Wide-field fundus photograph from neonatal ROP screening · 640x480px · acquired on the Clarity RetCam 3.
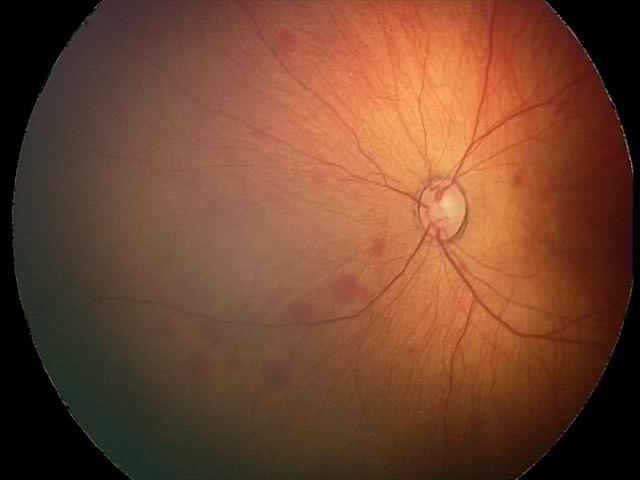

Screening diagnosis = retinal hemorrhages.